IOP (pneumatic tonometry): 14 mmHg. Age 50. Refractive error: -4 -1 x 95. 30° FOV: 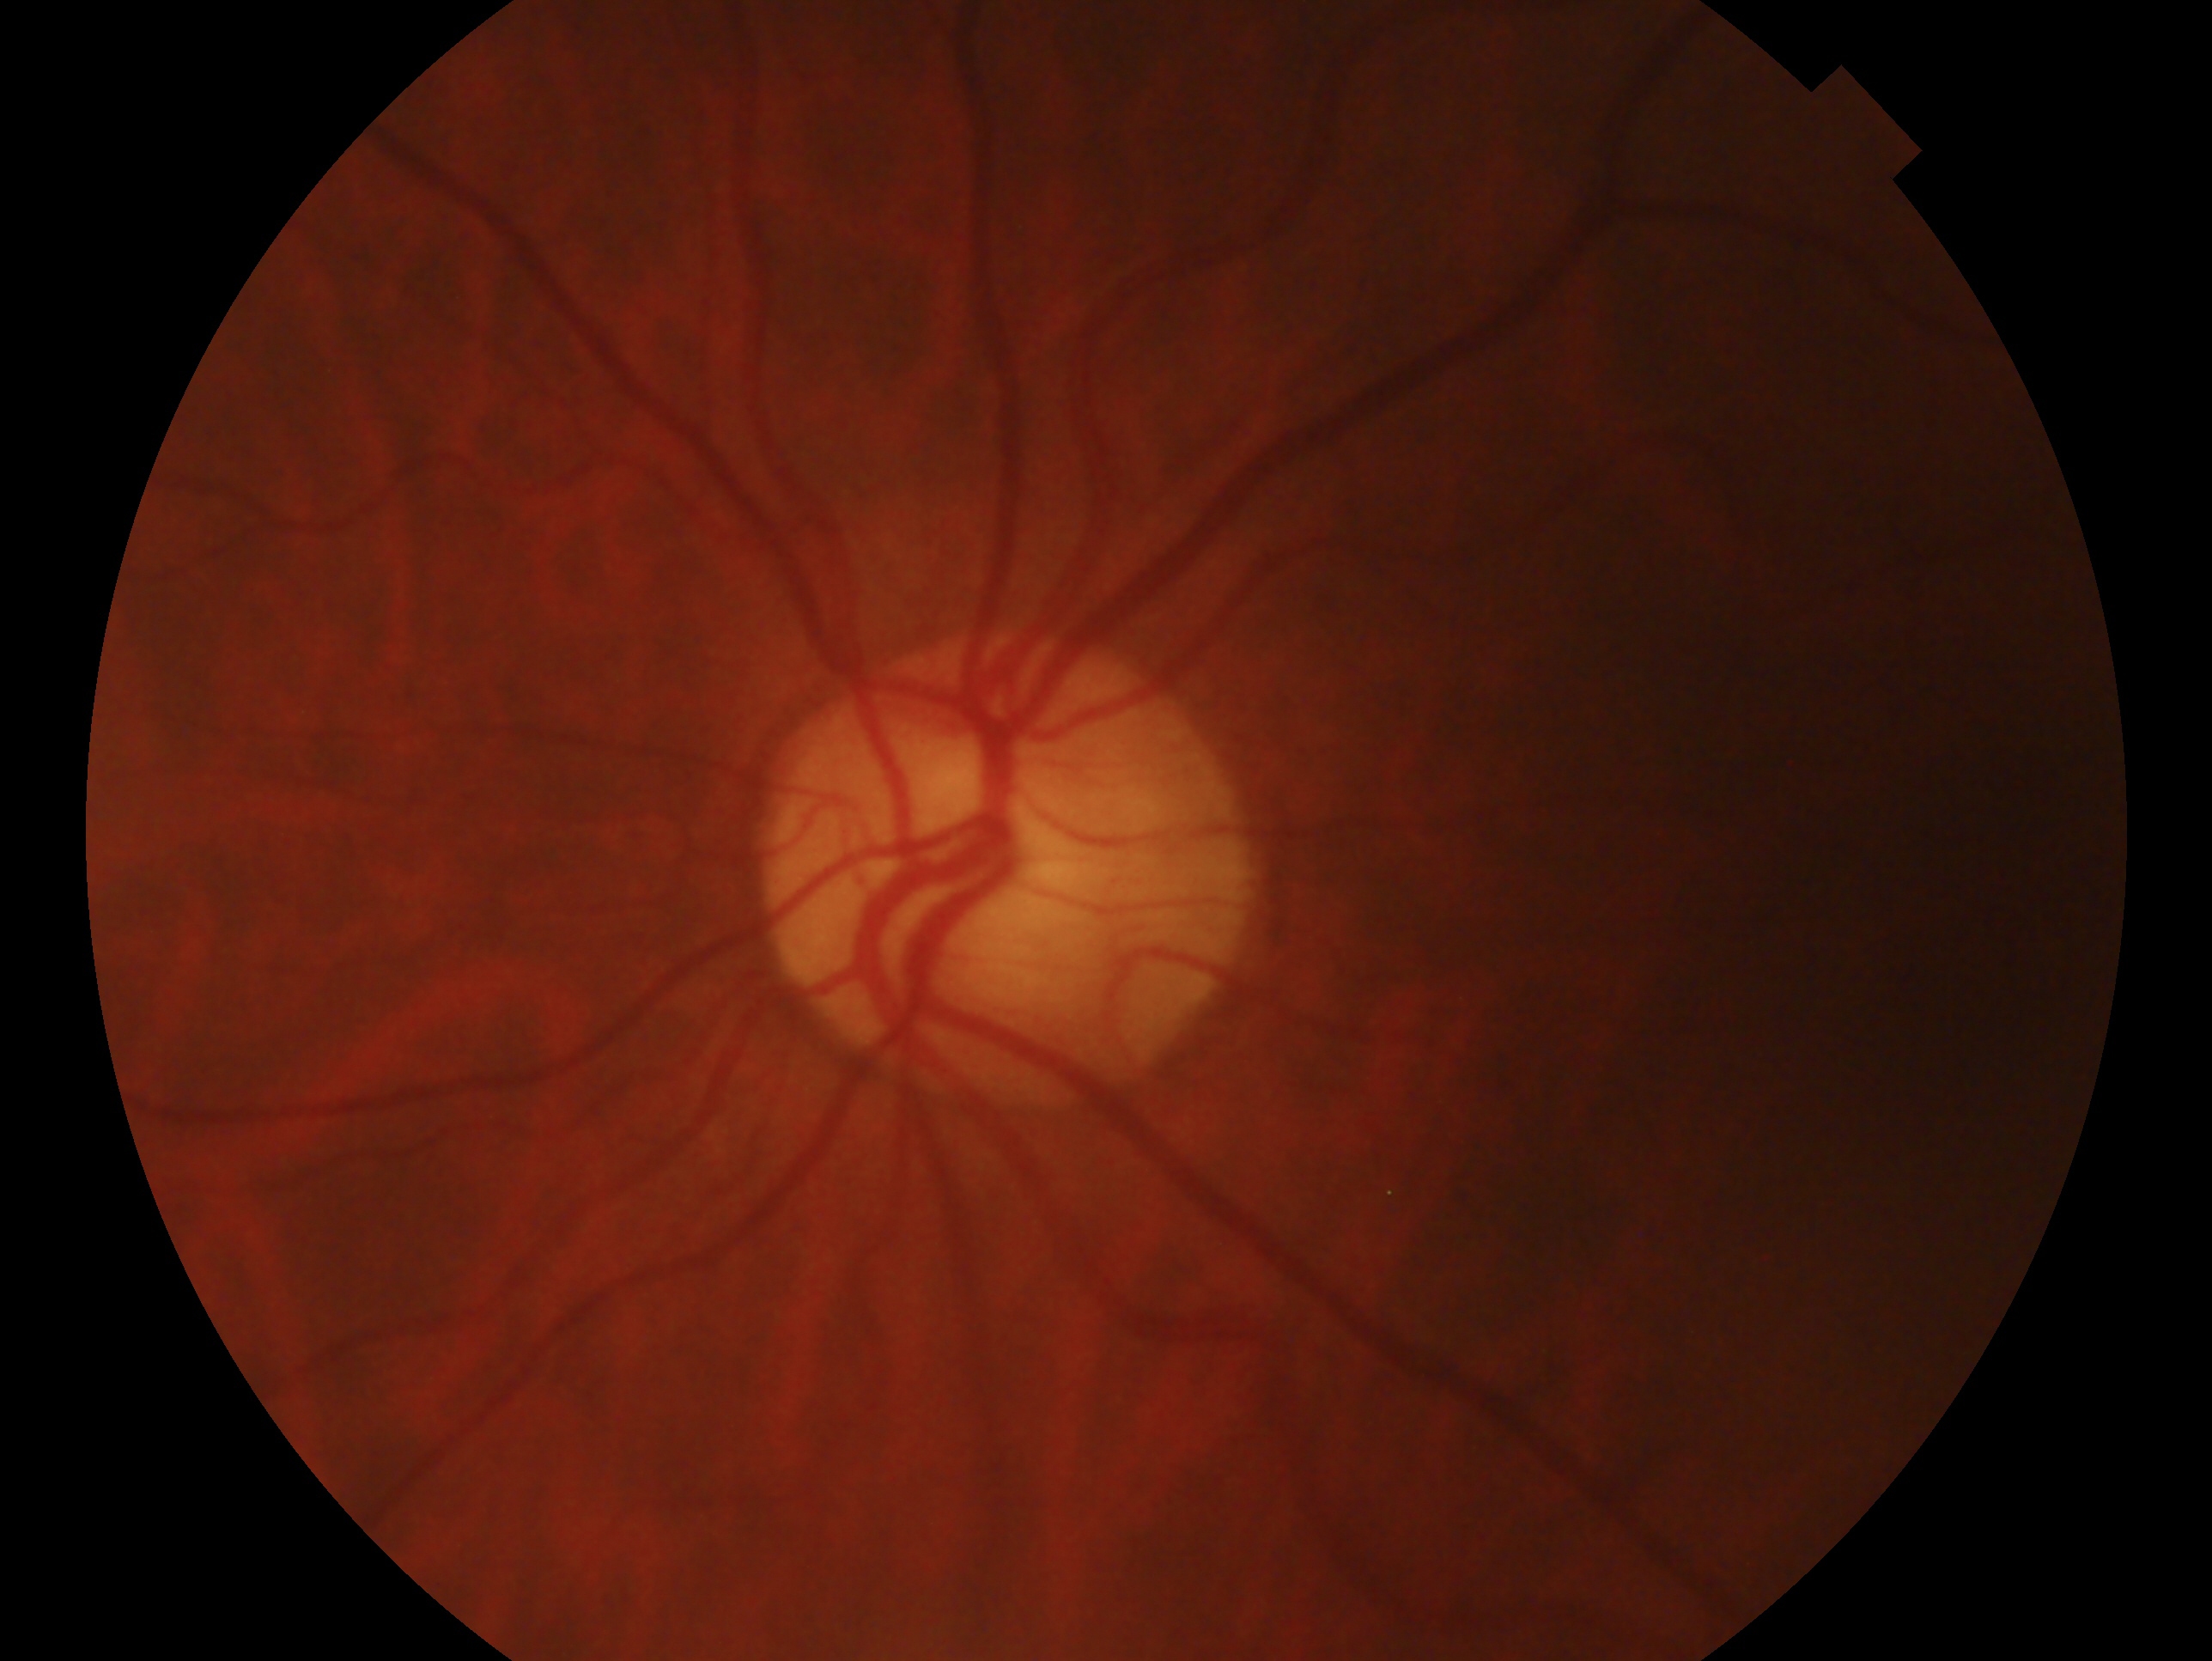
Glaucoma status: negative for glaucoma.
This is the OS.